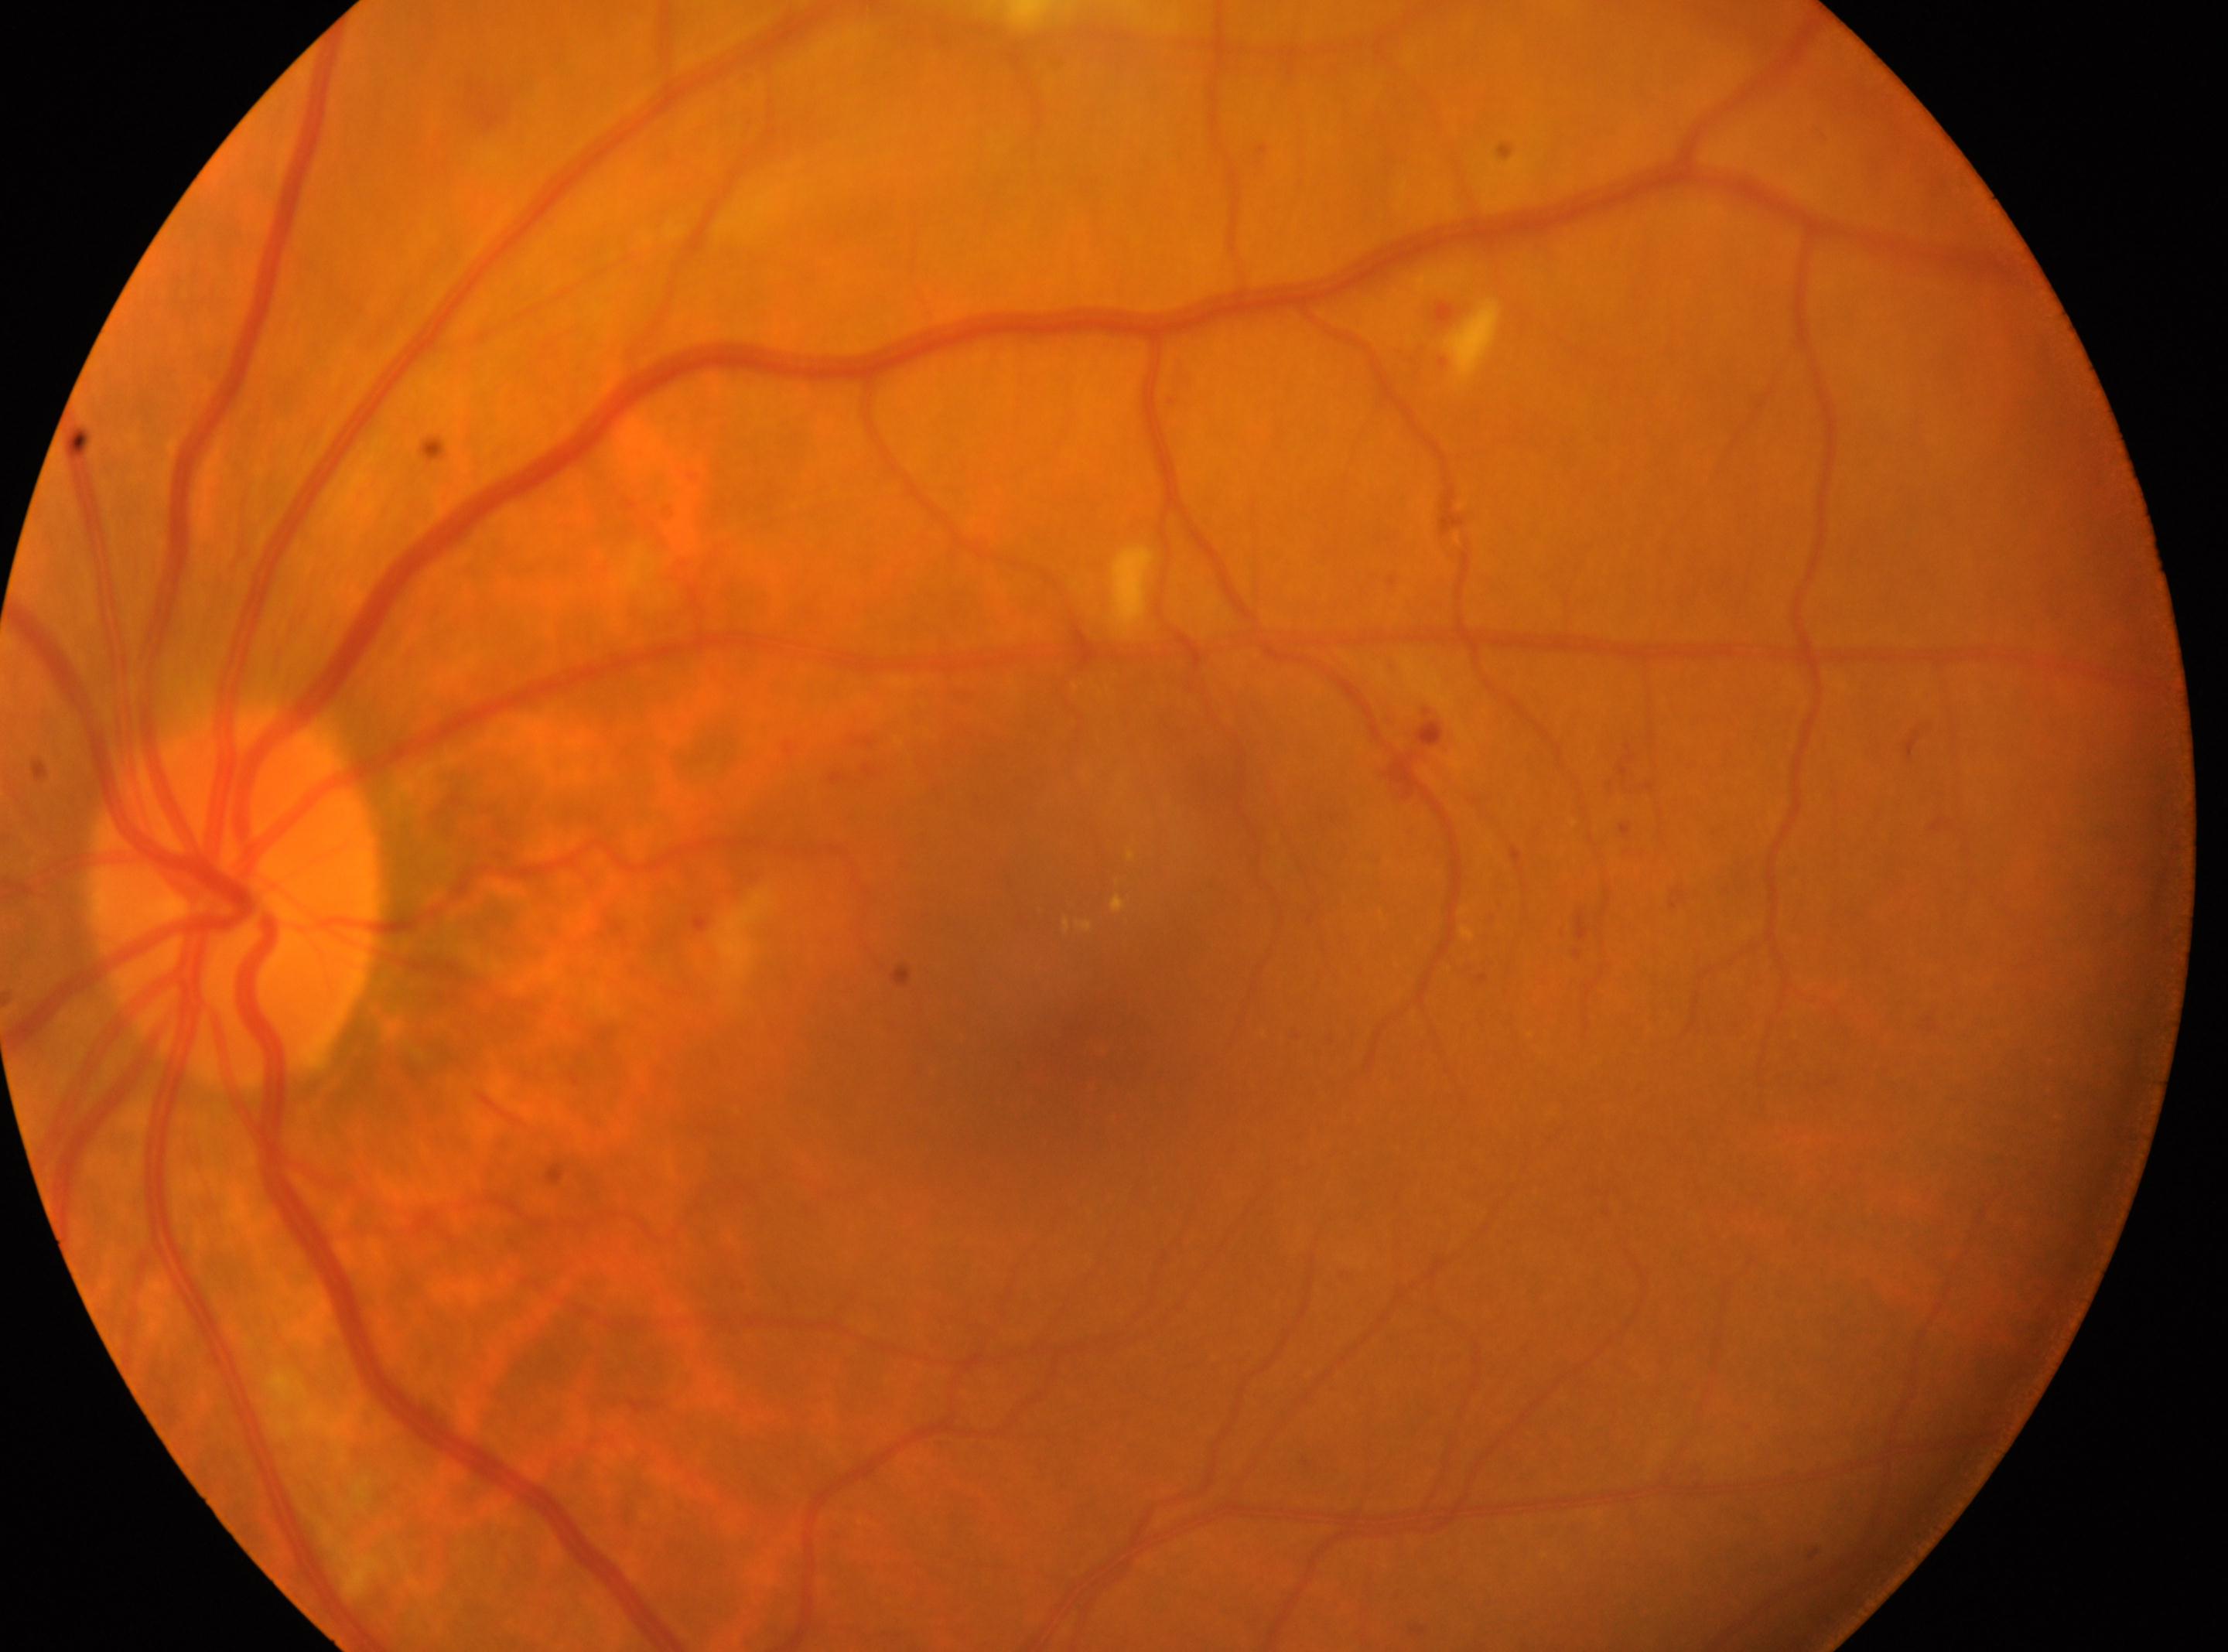
DR class: non-proliferative diabetic retinopathy. Eye: the left eye. The fovea center is at (1075, 1058). Diabetic retinopathy (DR) is 2/4. Optic nerve head: (238, 896).